Pupil-dilated; color fundus image.
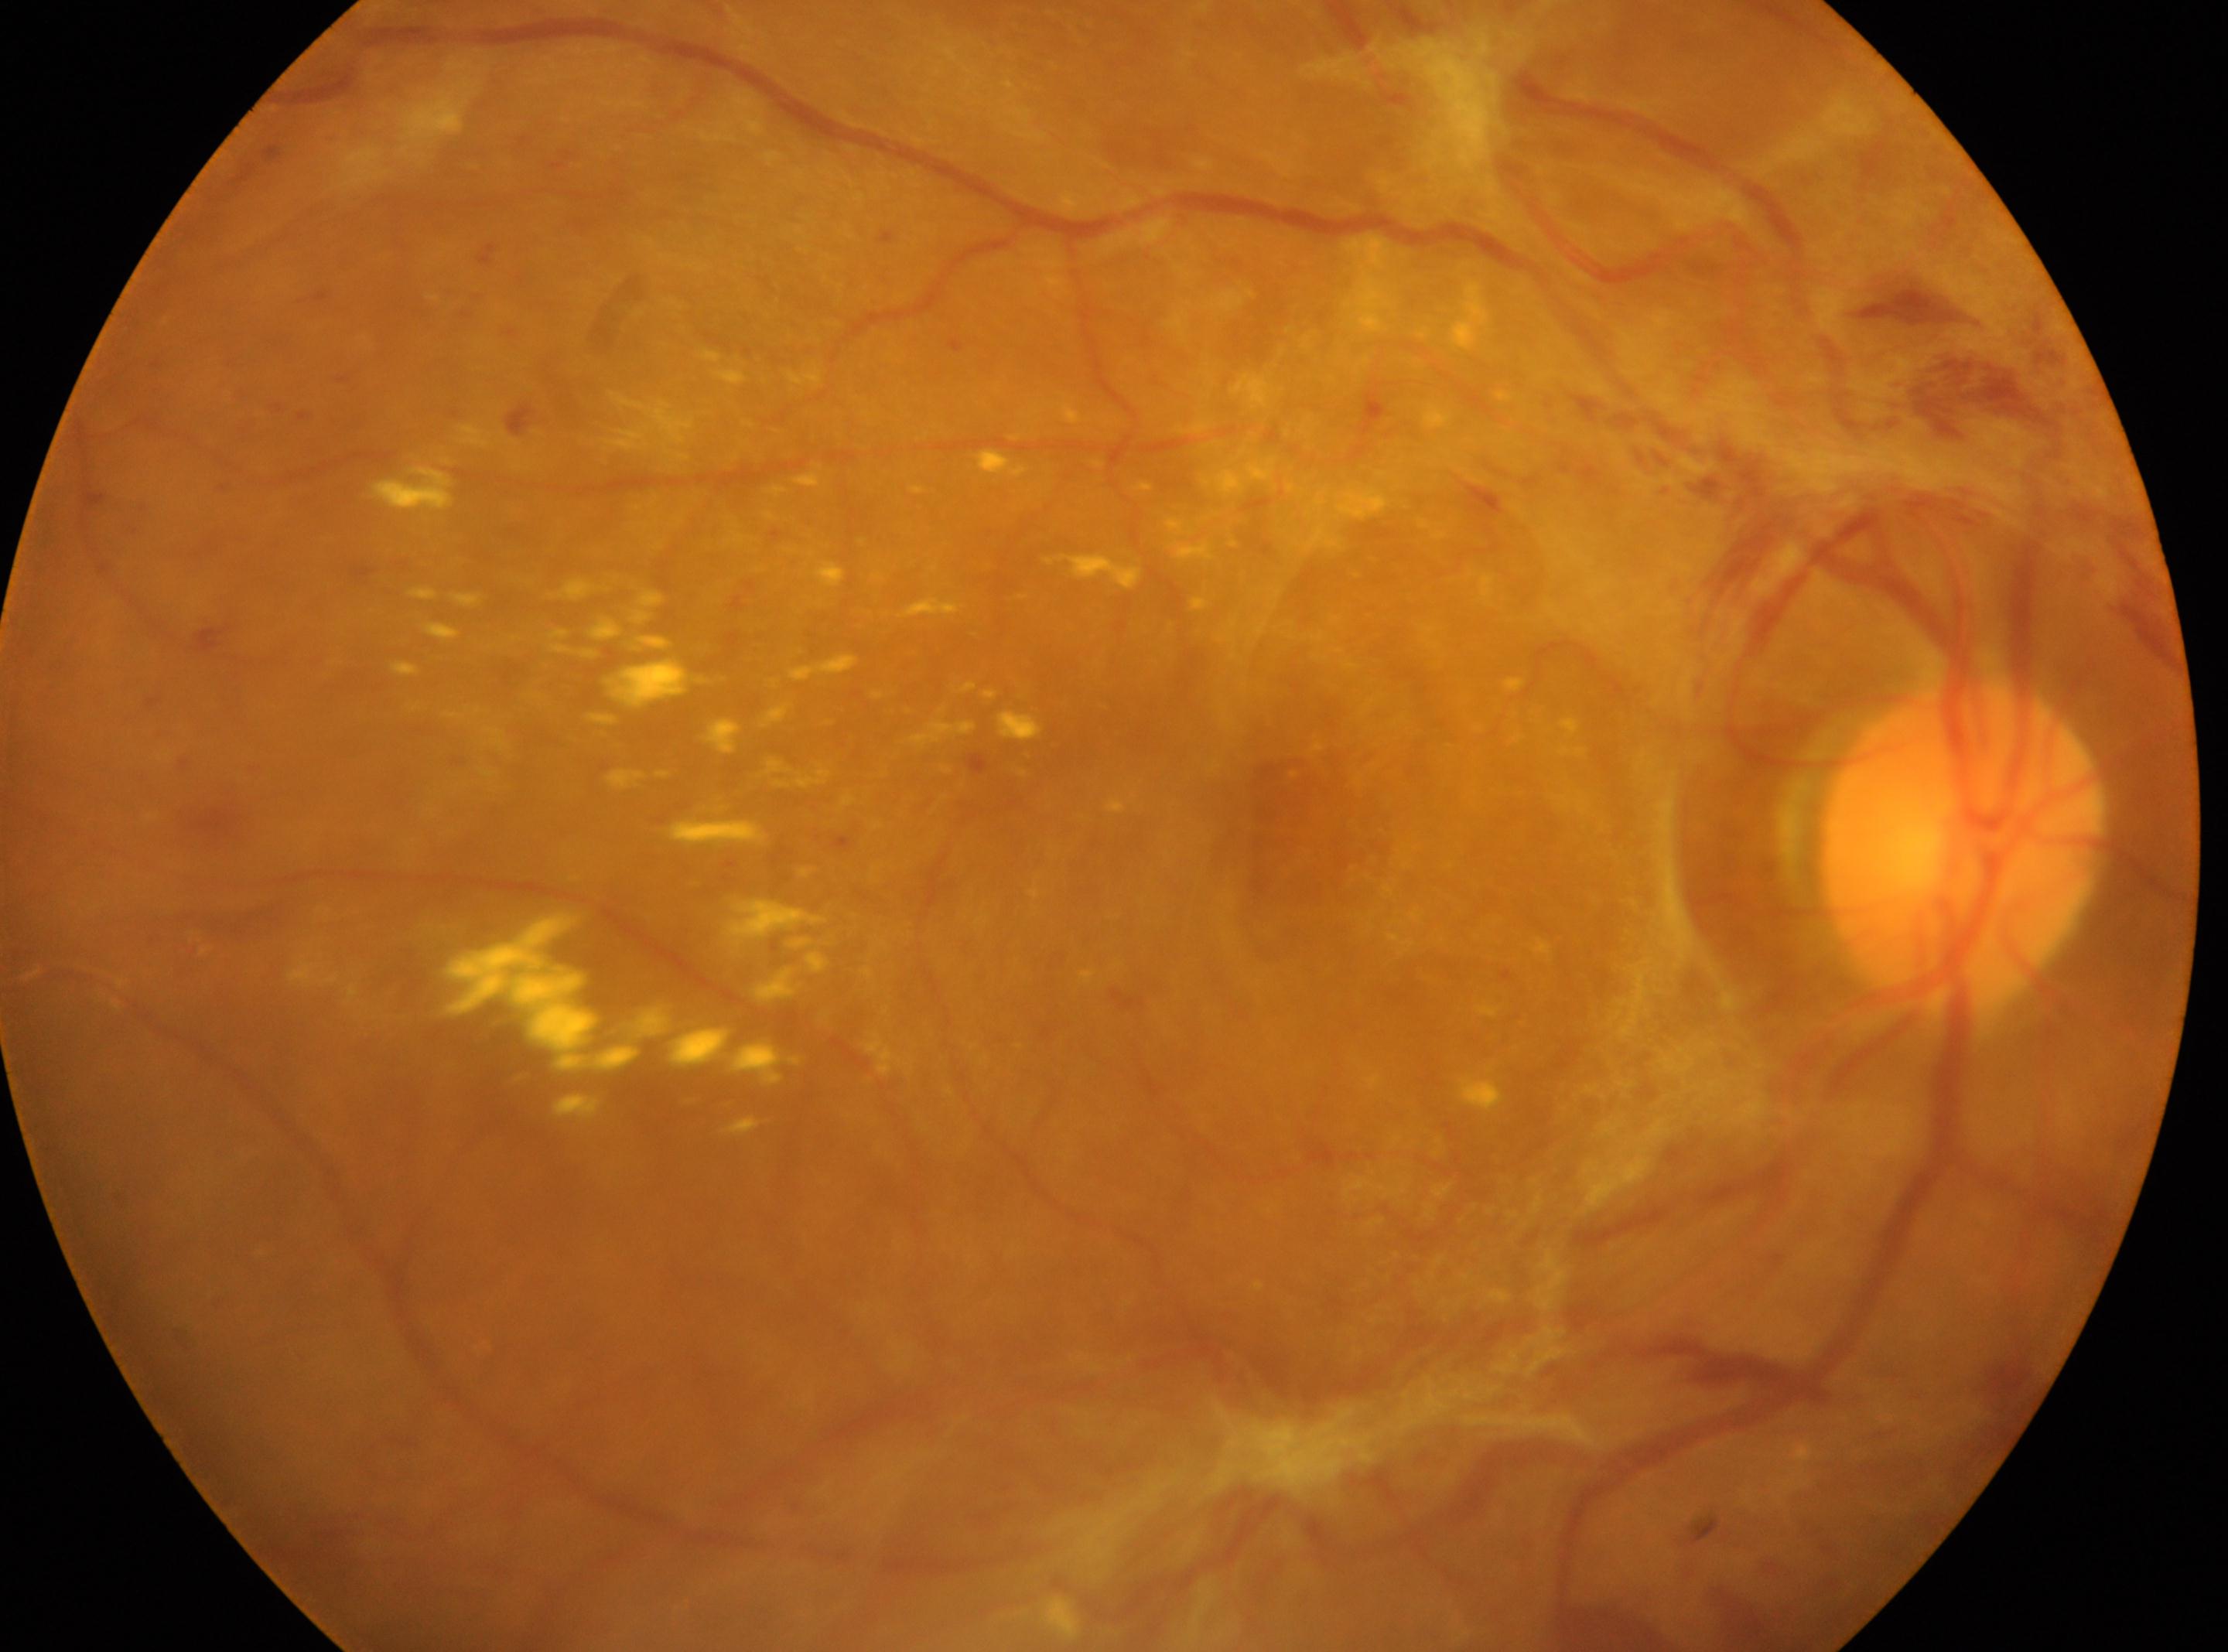   eye: oculus dexter
  optic_disc: [1964, 852]
  dr_grade: PDR (grade 4)
  dr_category: proliferative diabetic retinopathy
  fovea: [1256, 831]